2212 x 1672 pixels:
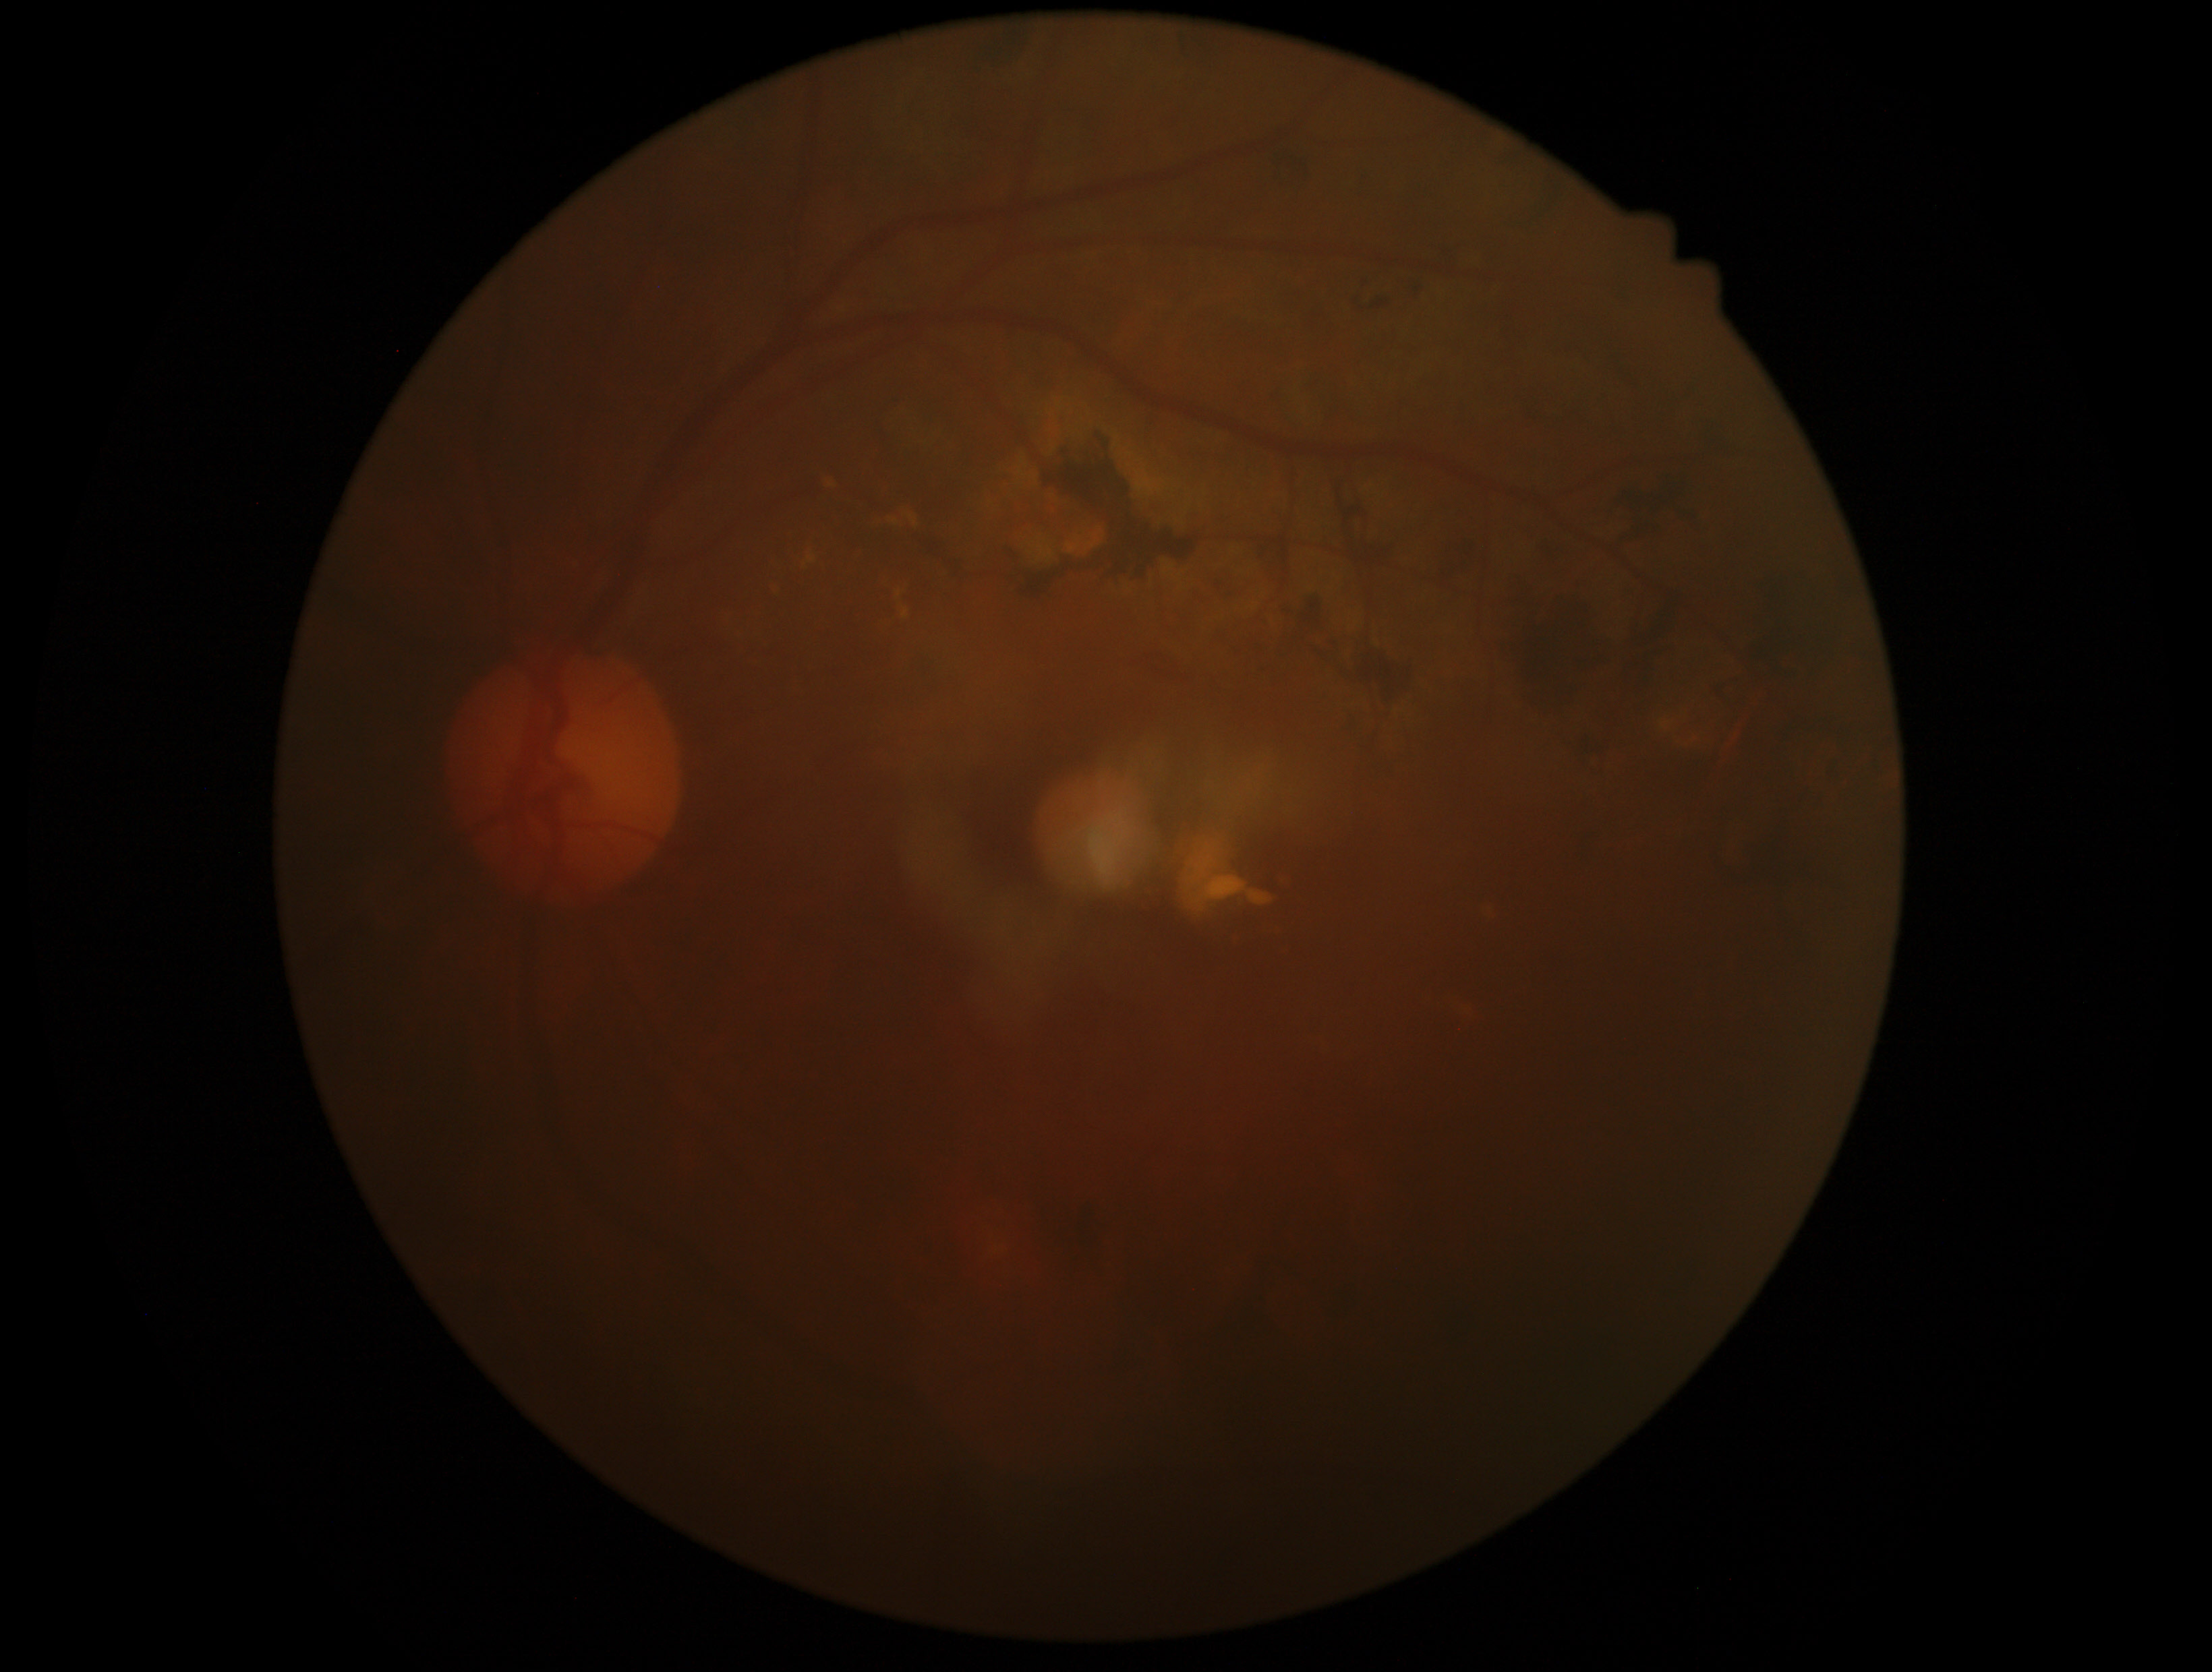
Findings:
* diabetic retinopathy (DR): grade 2 (moderate NPDR)